45-degree field of view: 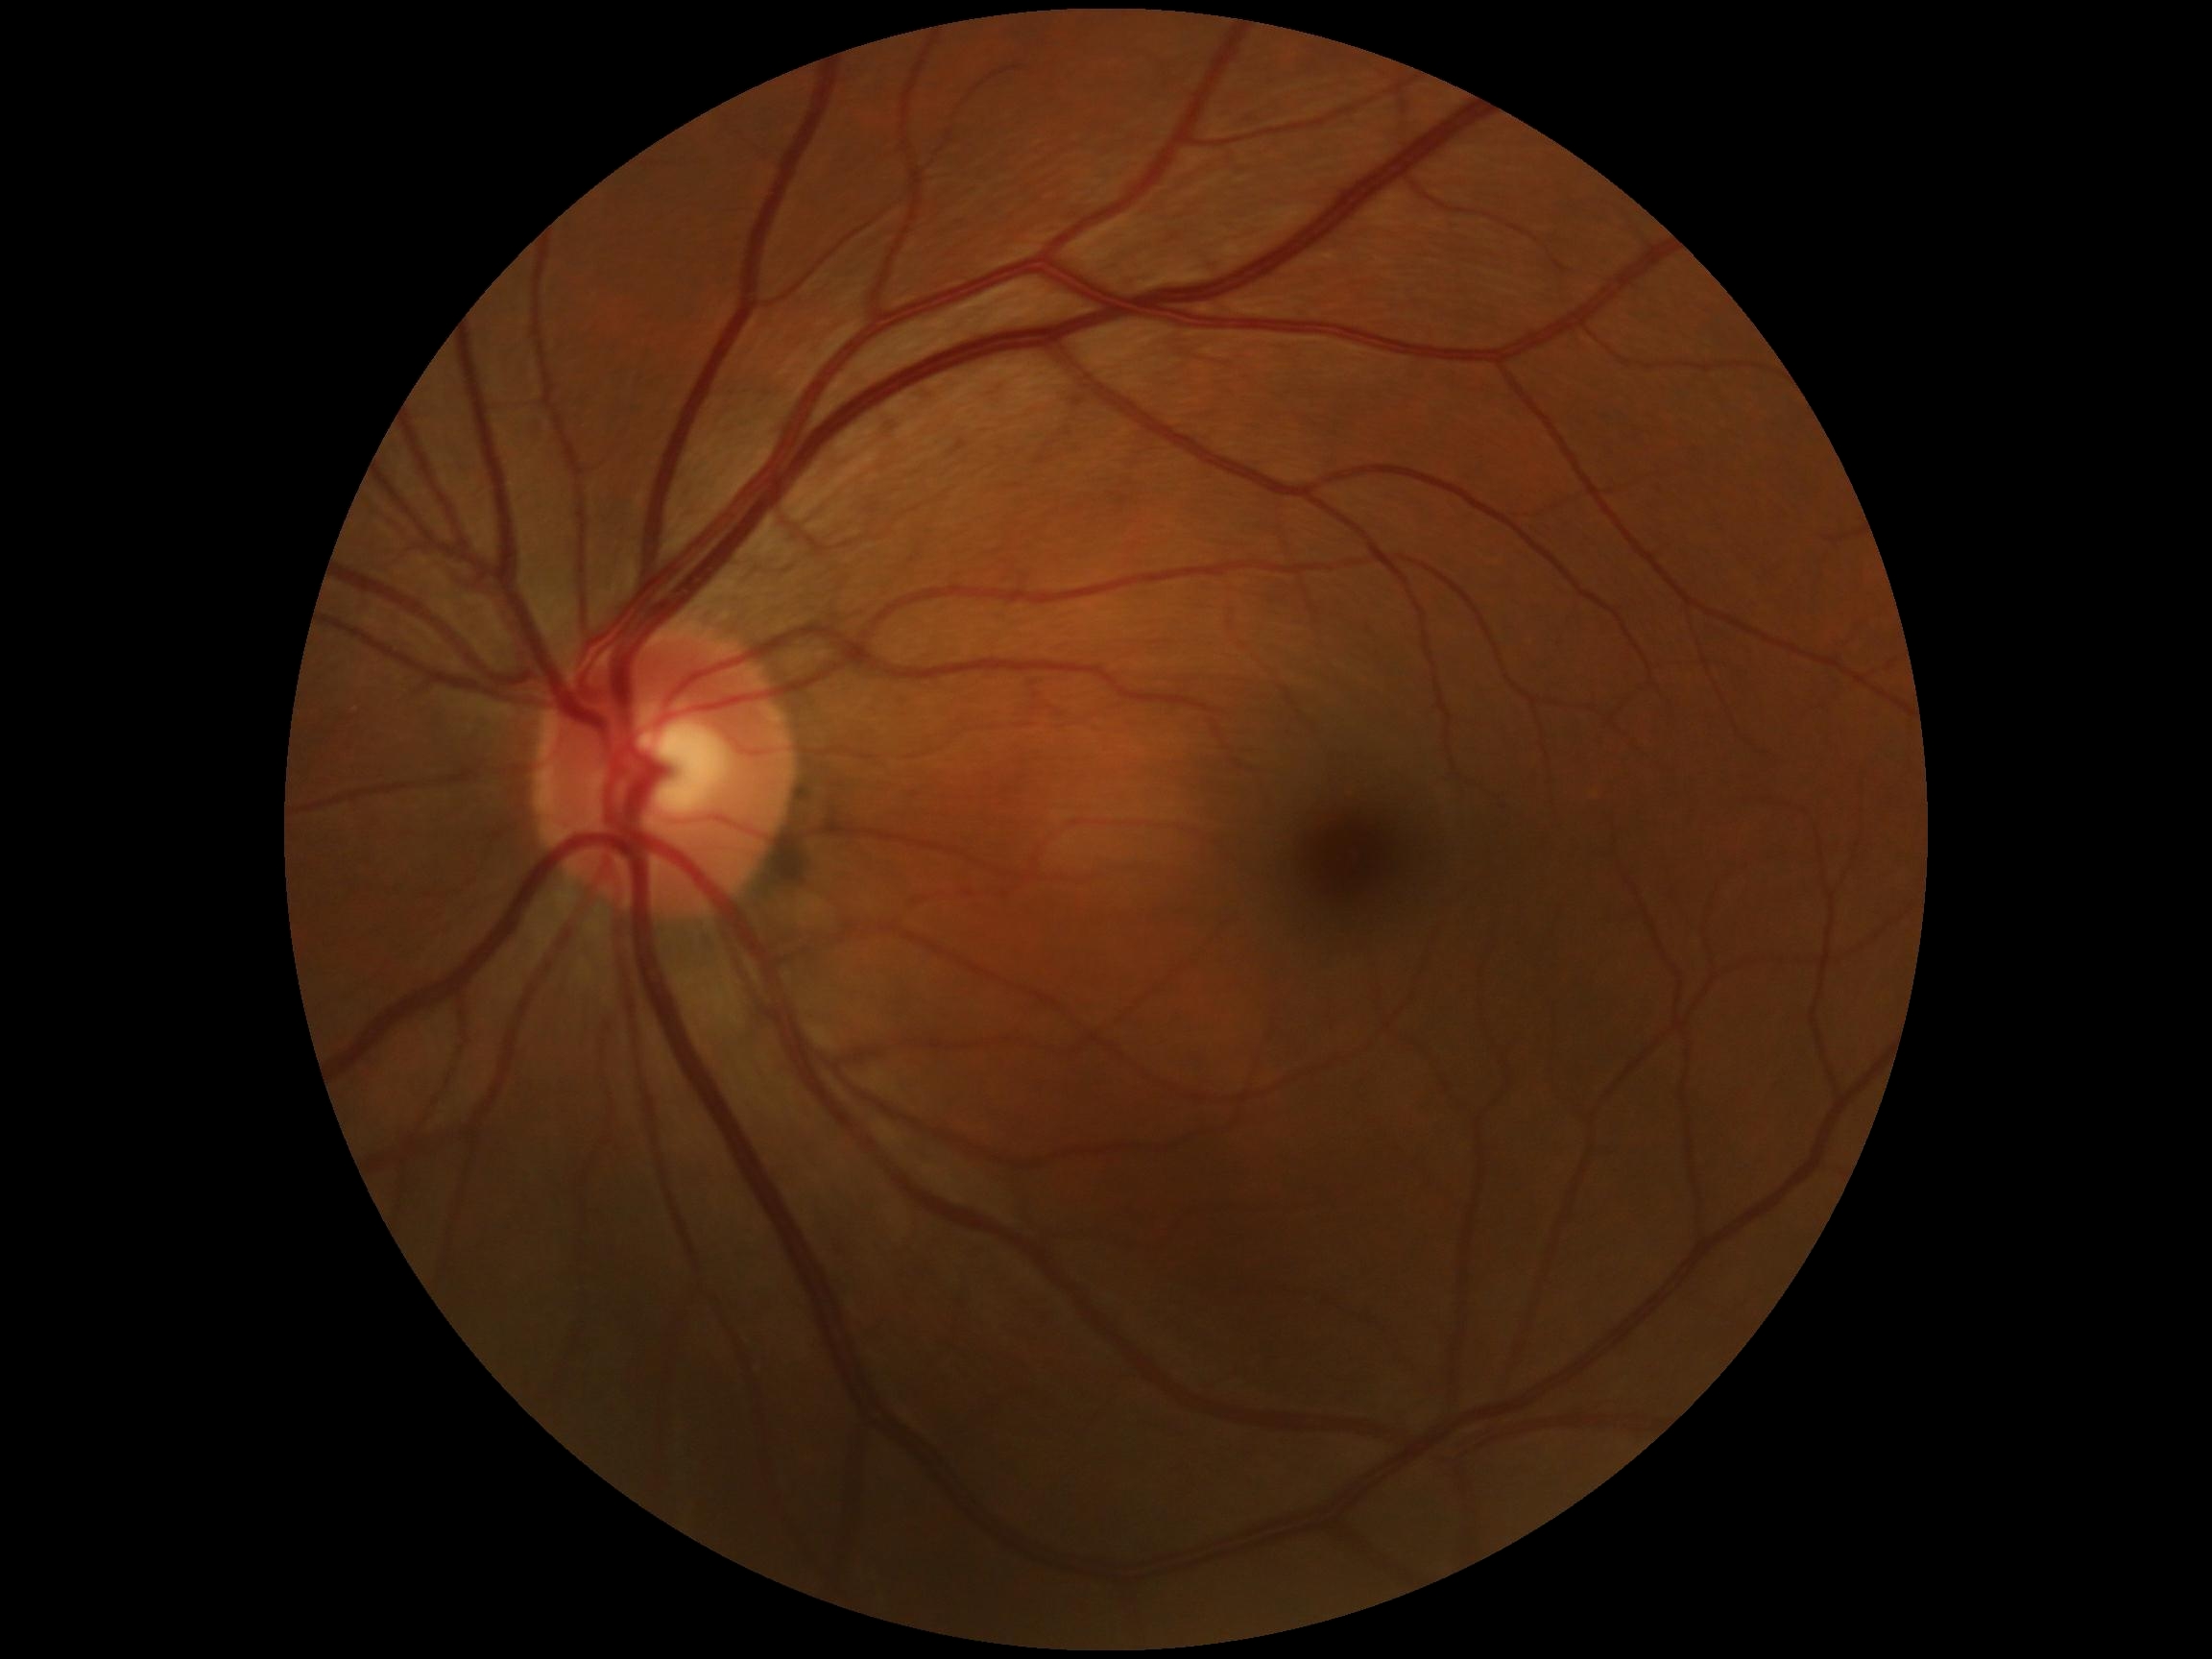
DR stage: grade 0.